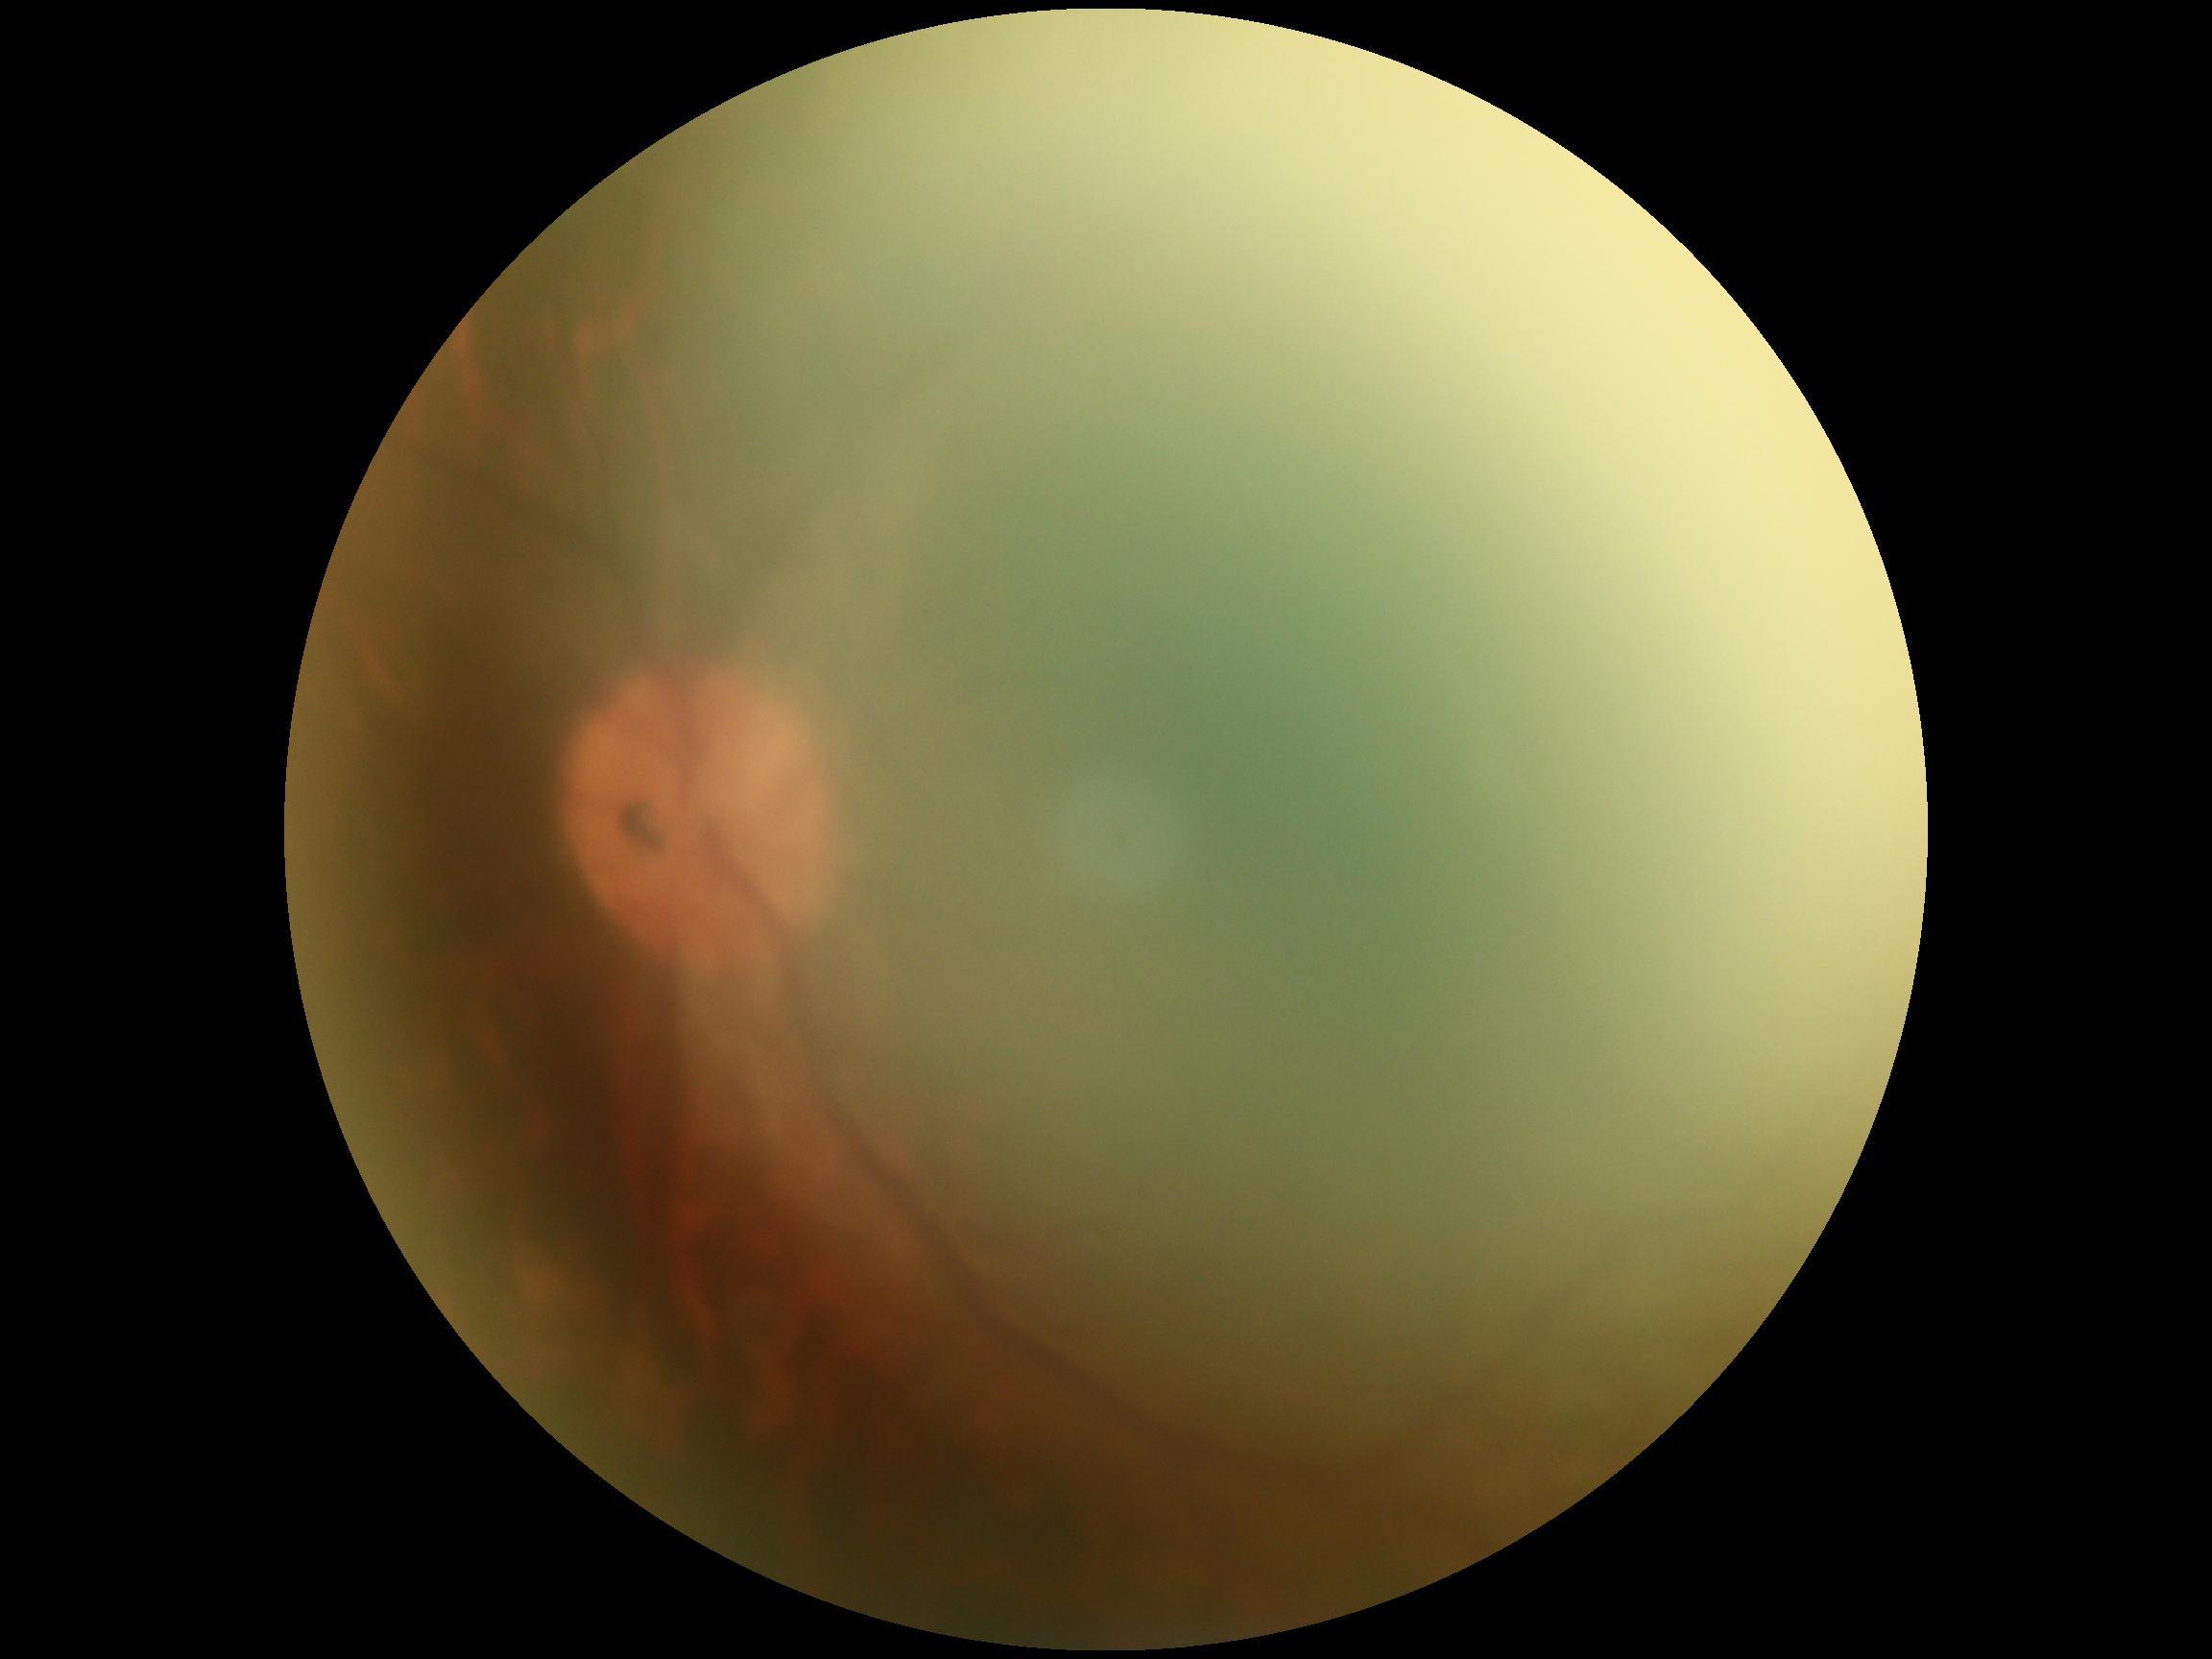
Image quality is insufficient for diabetic retinopathy assessment. DR: ungradable due to poor image quality.